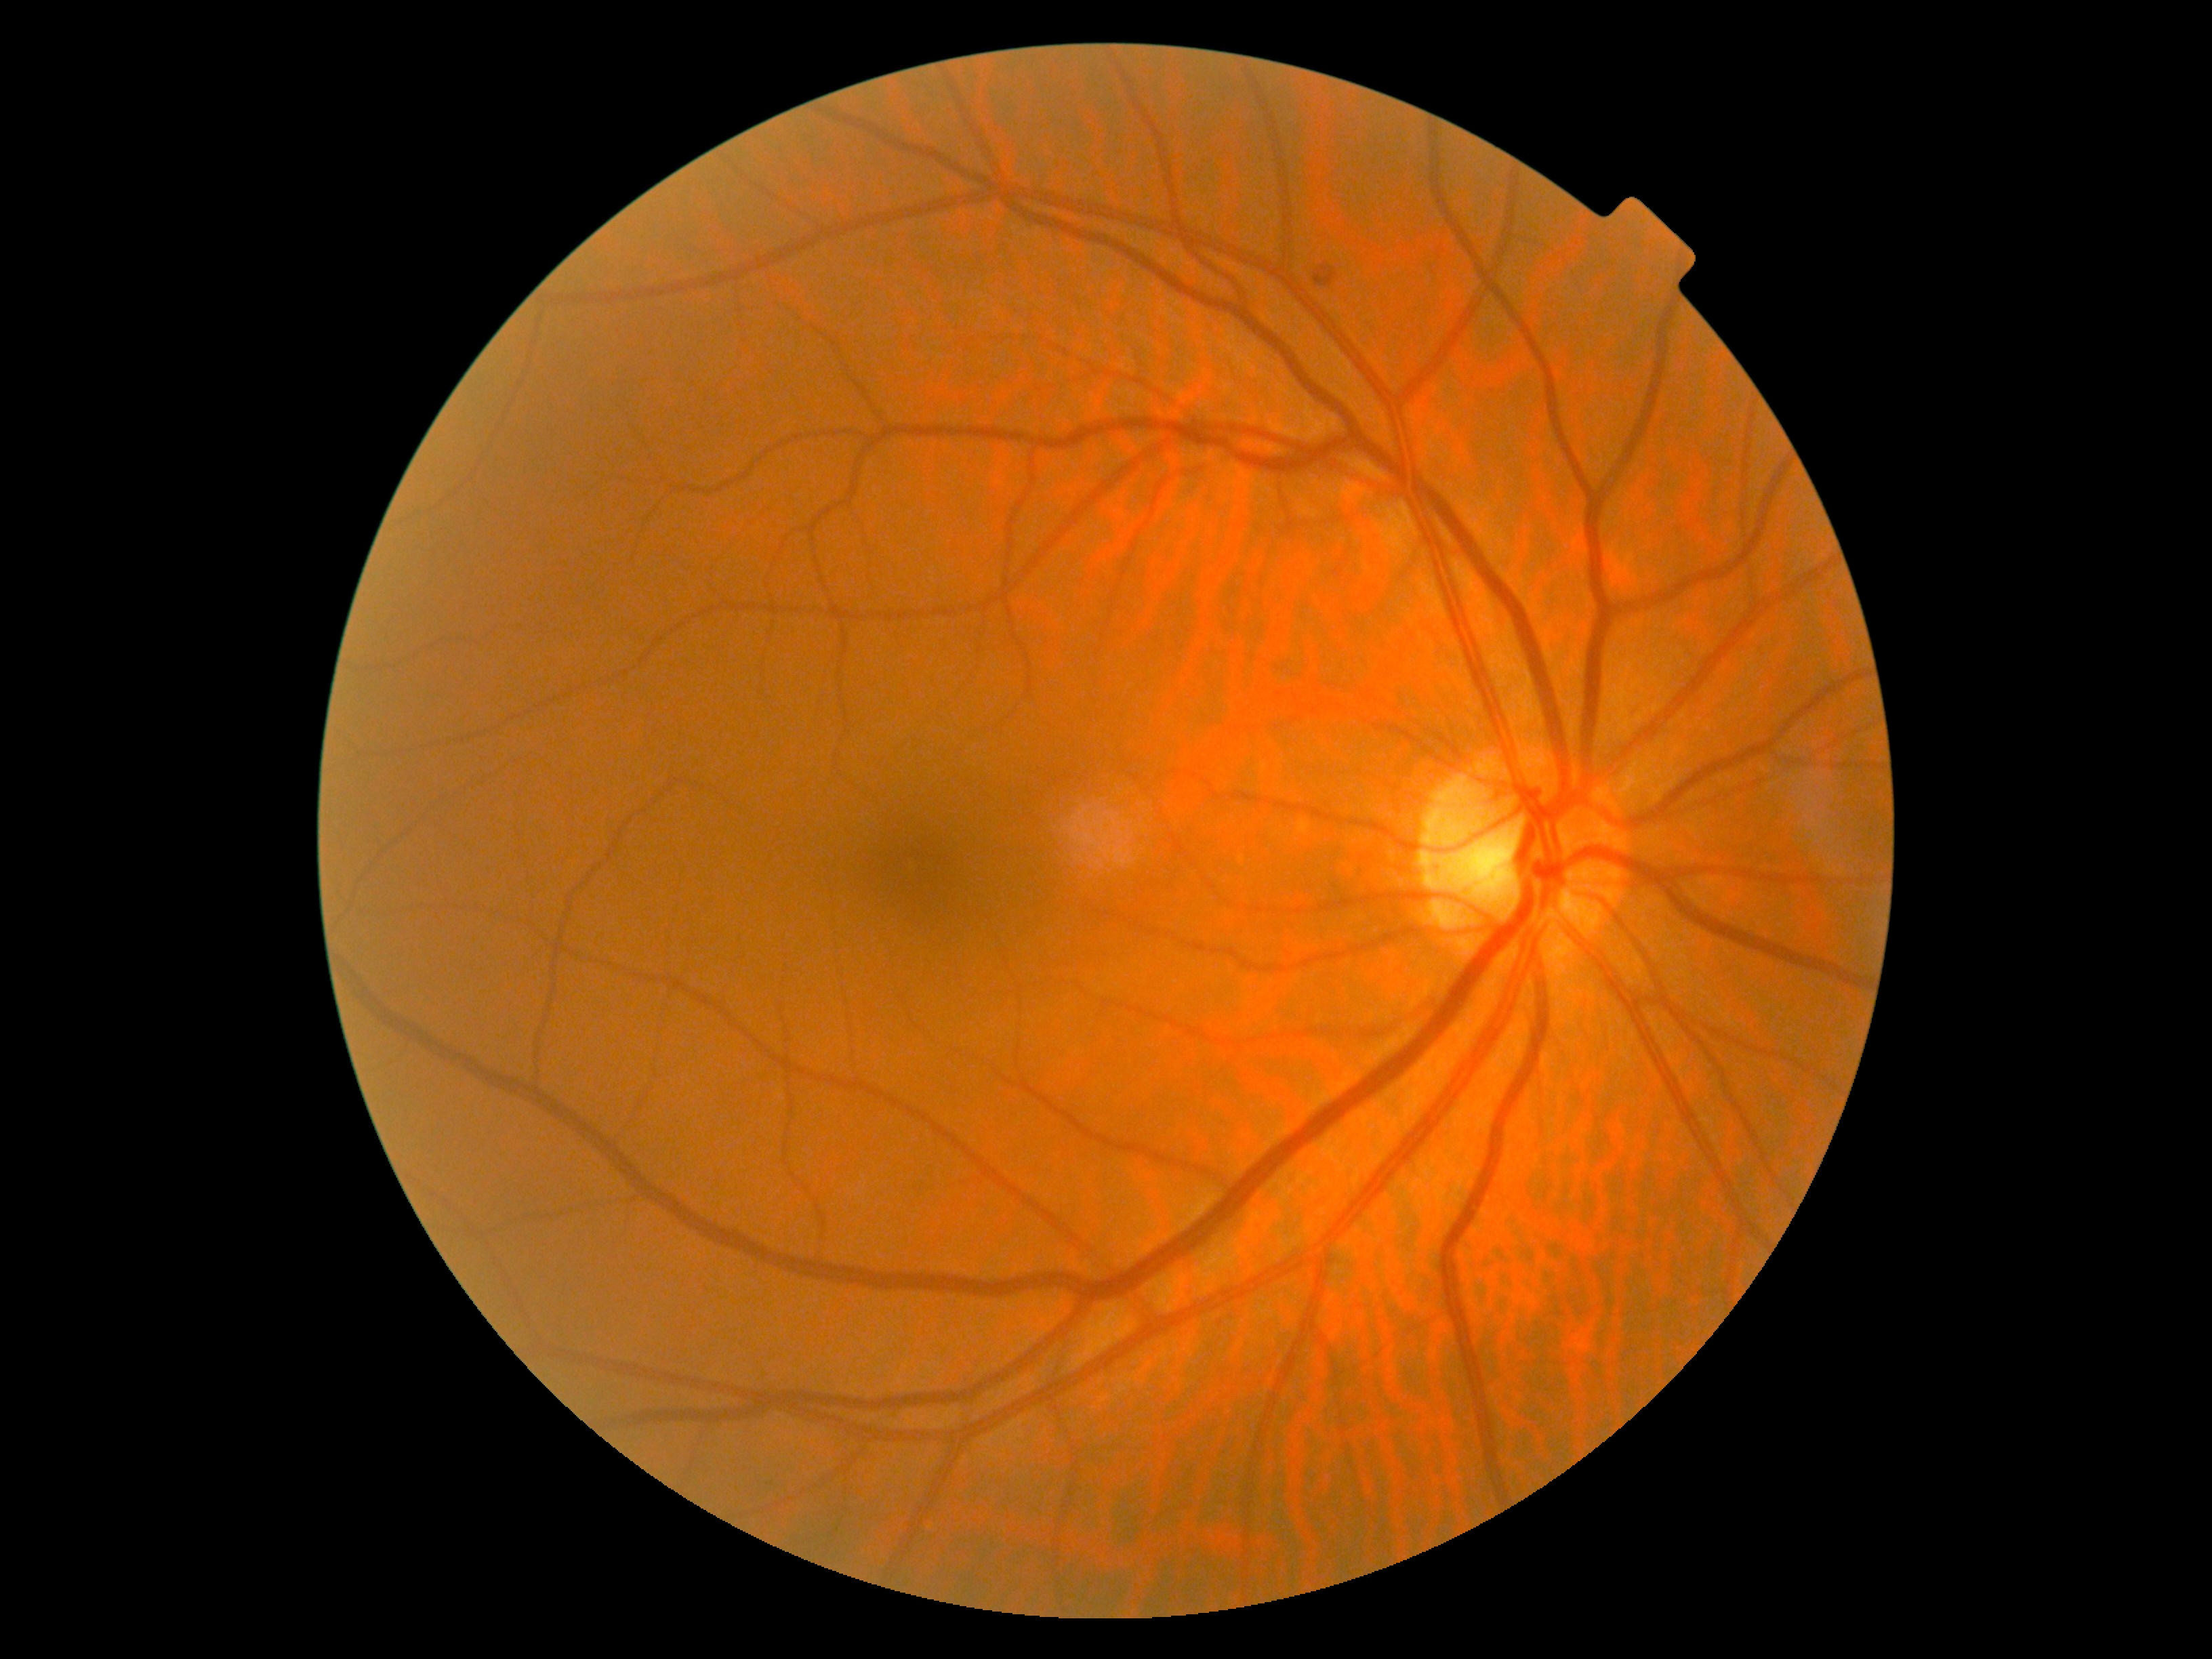 DR stage is 2.